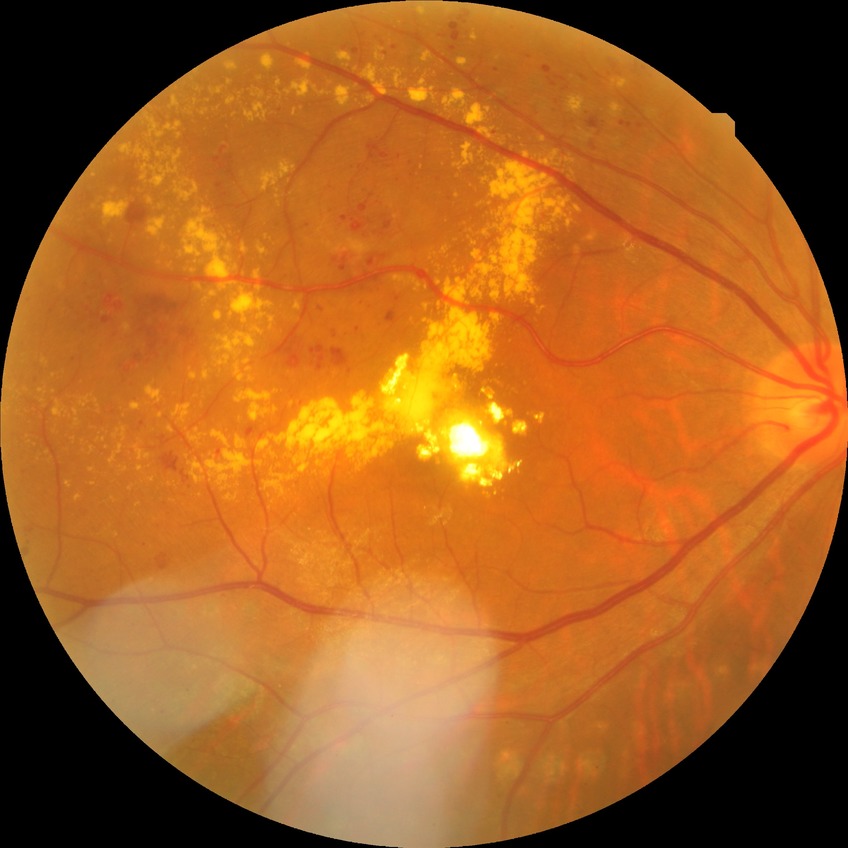

Assessment:
- diabetic retinopathy (DR): SDR (simple diabetic retinopathy)